2352x1568px — 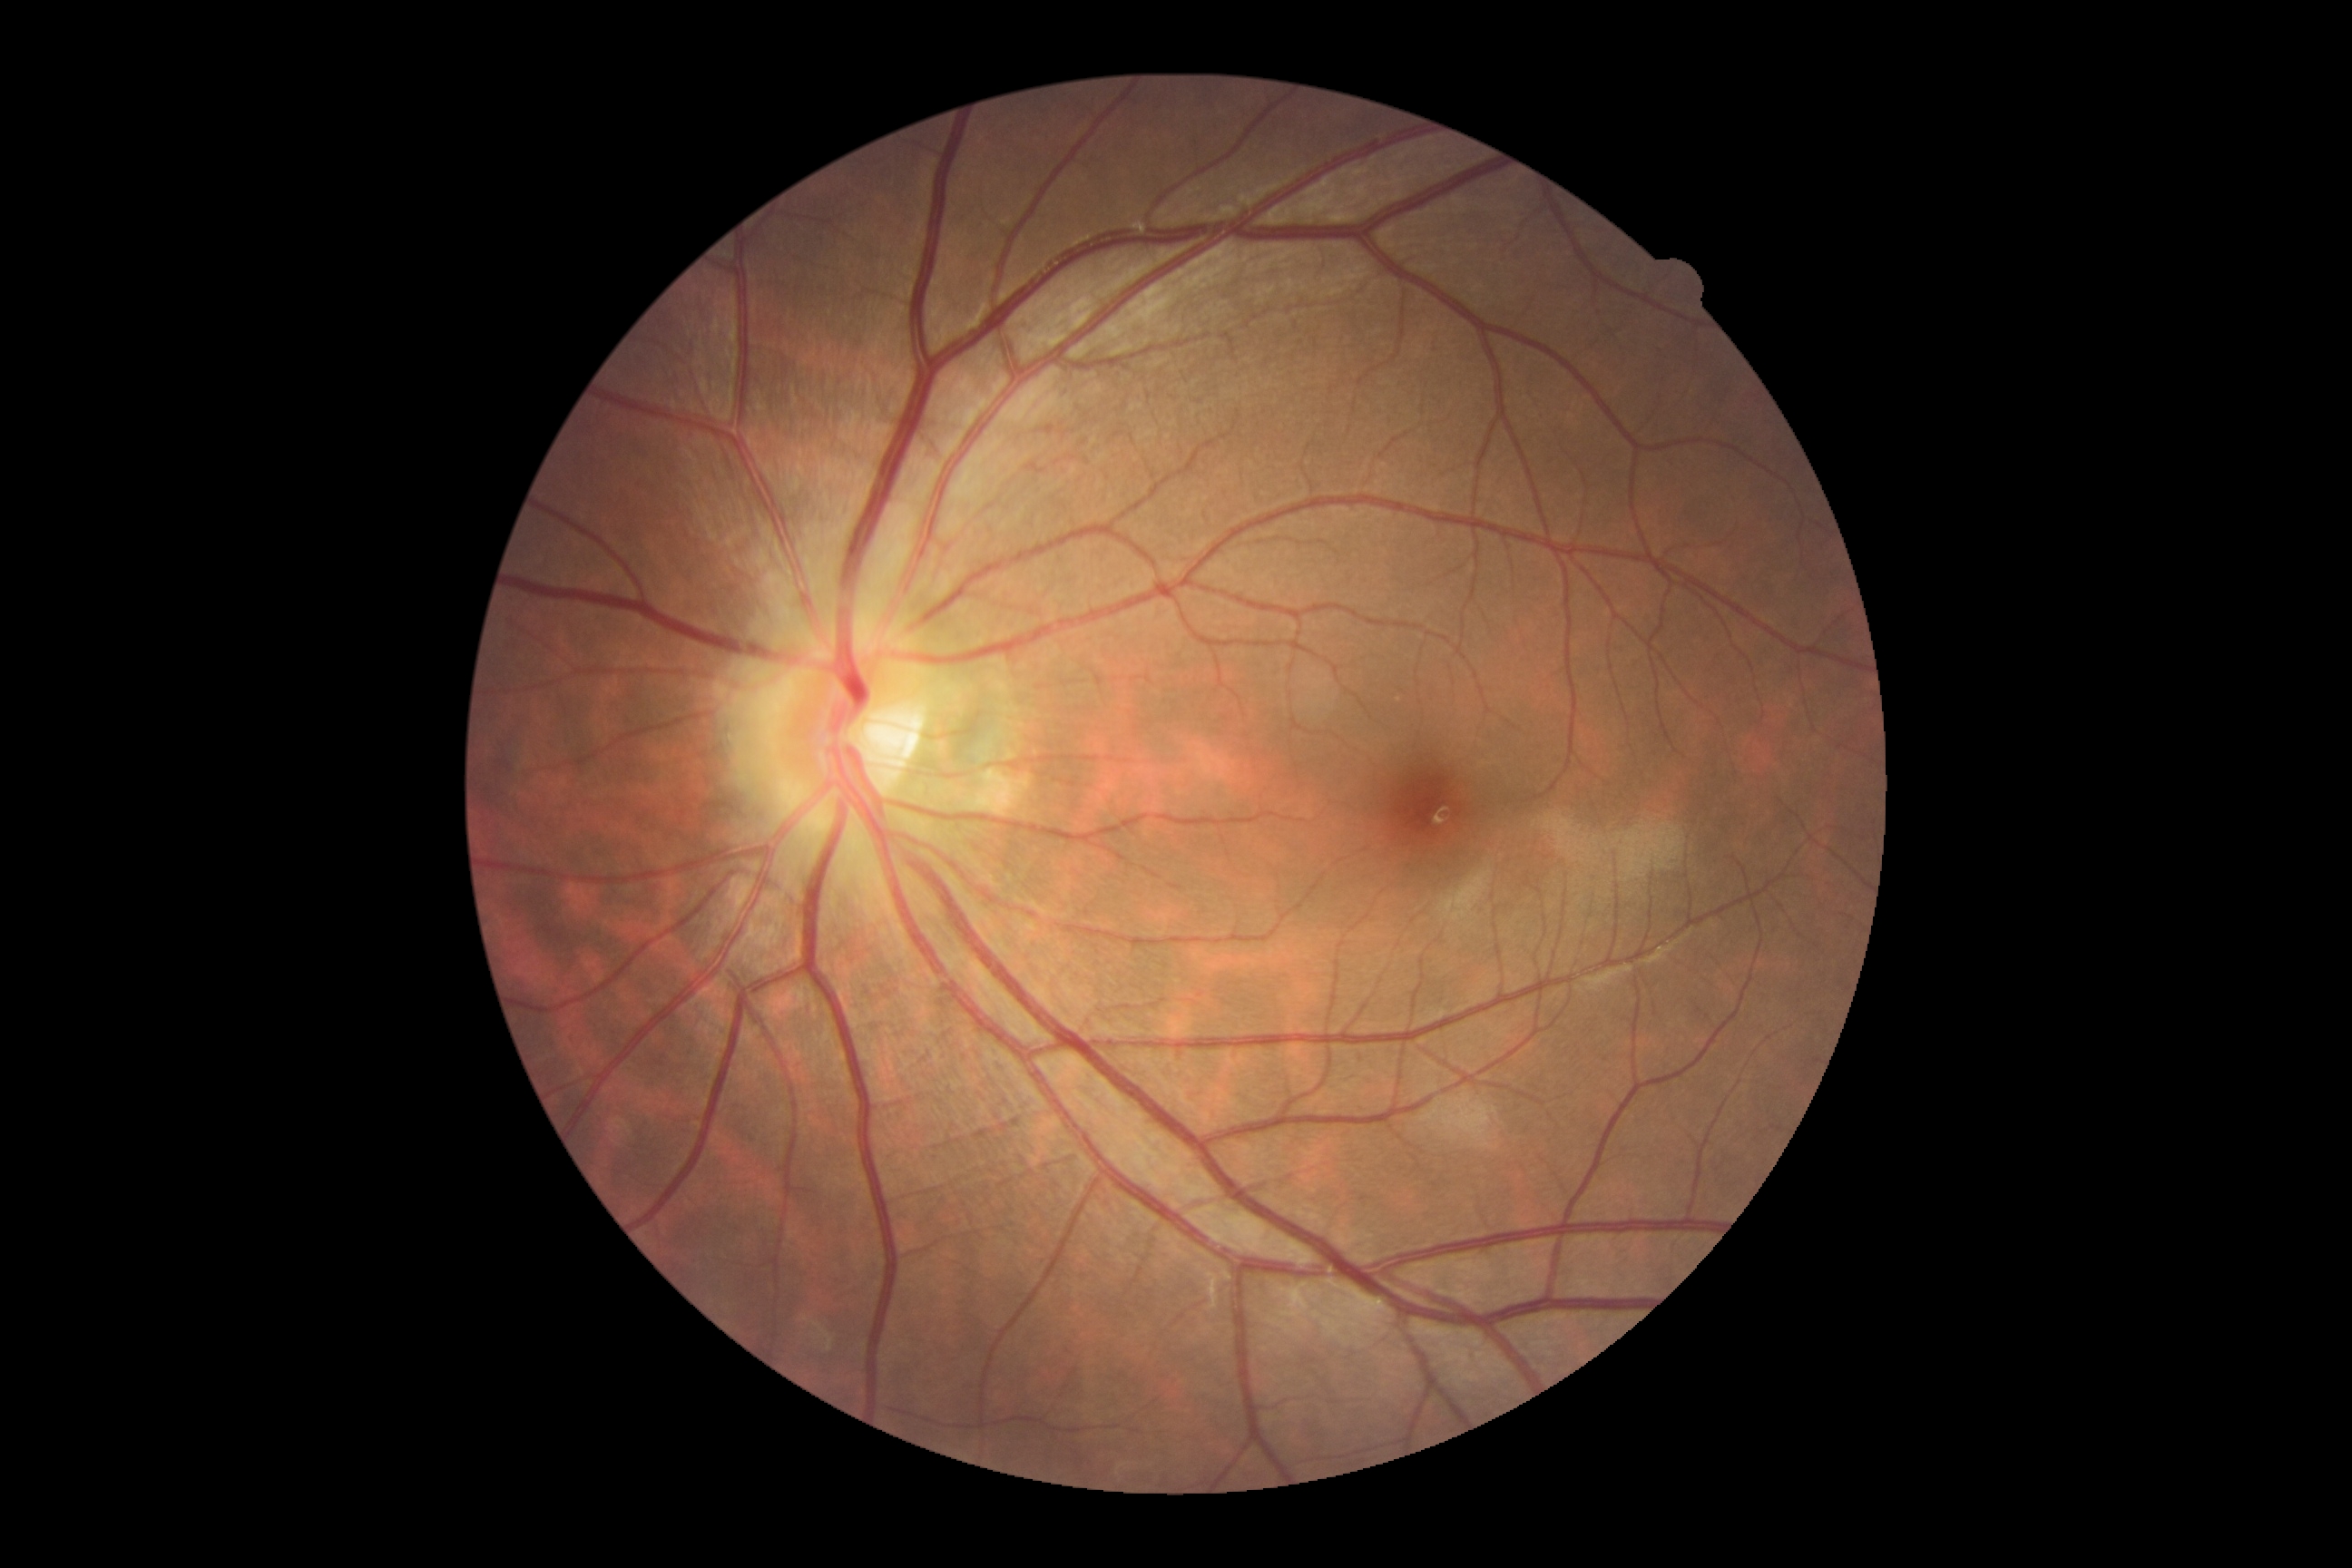 DR grade is no apparent diabetic retinopathy (0) — no visible signs of diabetic retinopathy.